Infant wide-field fundus photograph. Captured with the Natus RetCam Envision (130° field of view). Image size 1440x1080 — 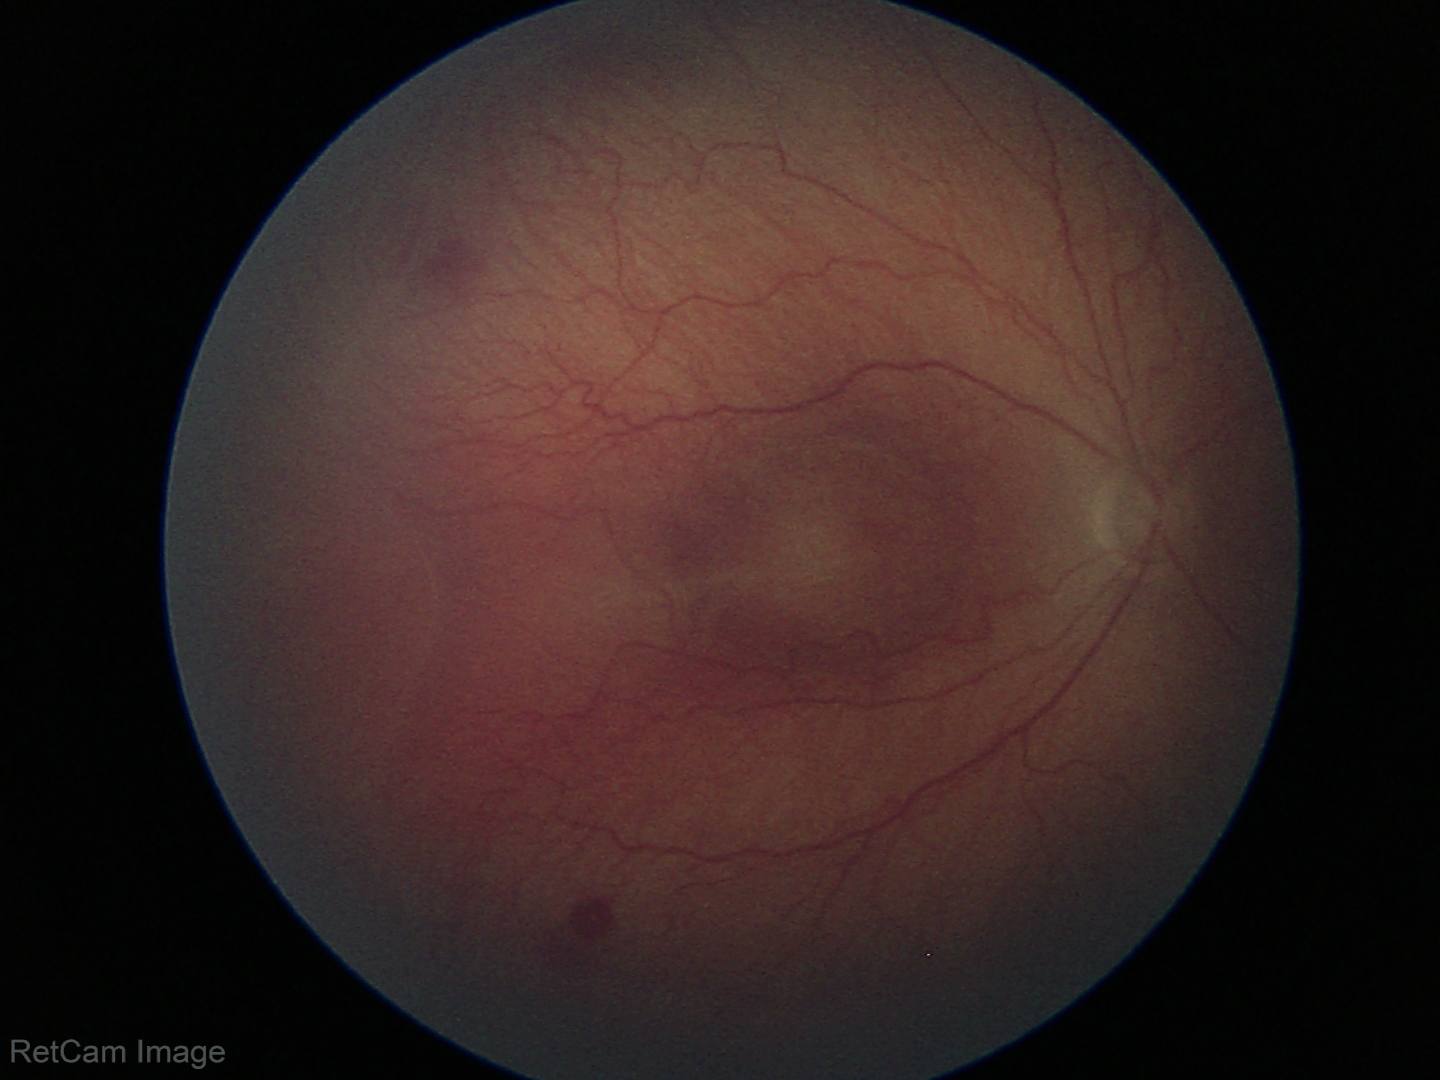

Screening diagnosis = ROP stage 2.